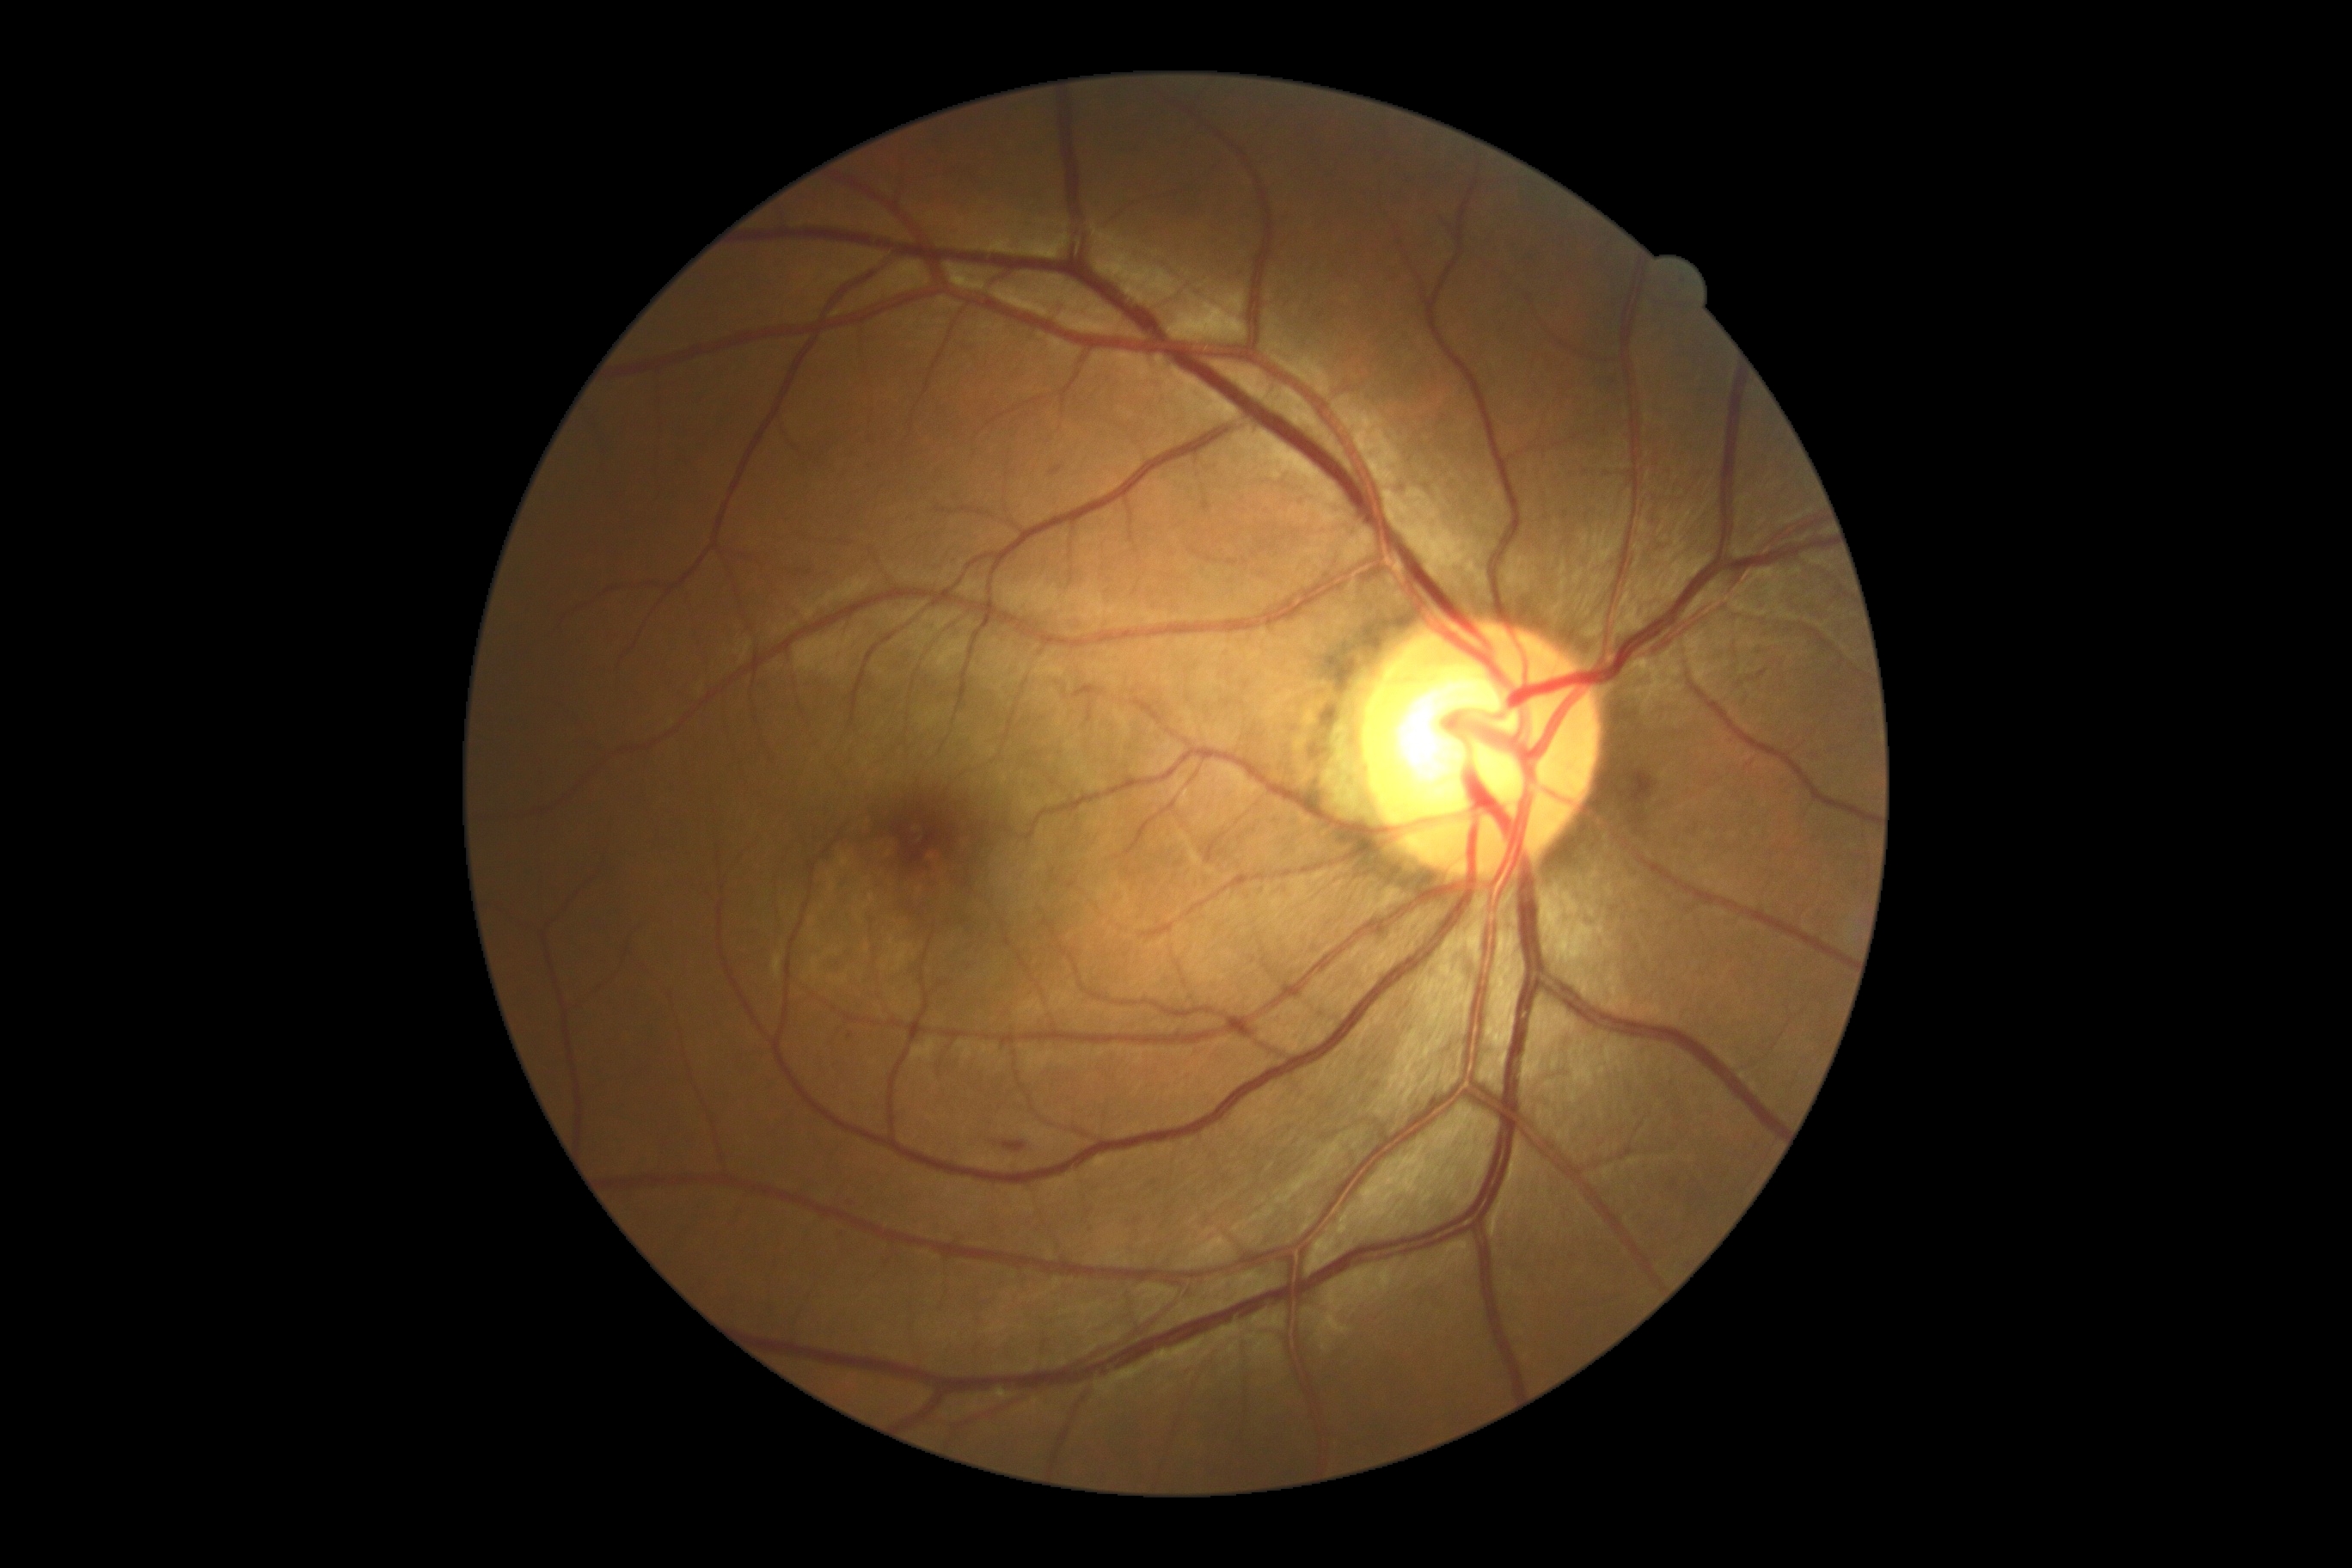

Disease class: non-proliferative diabetic retinopathy. DR severity: 2/4.